Color fundus image: 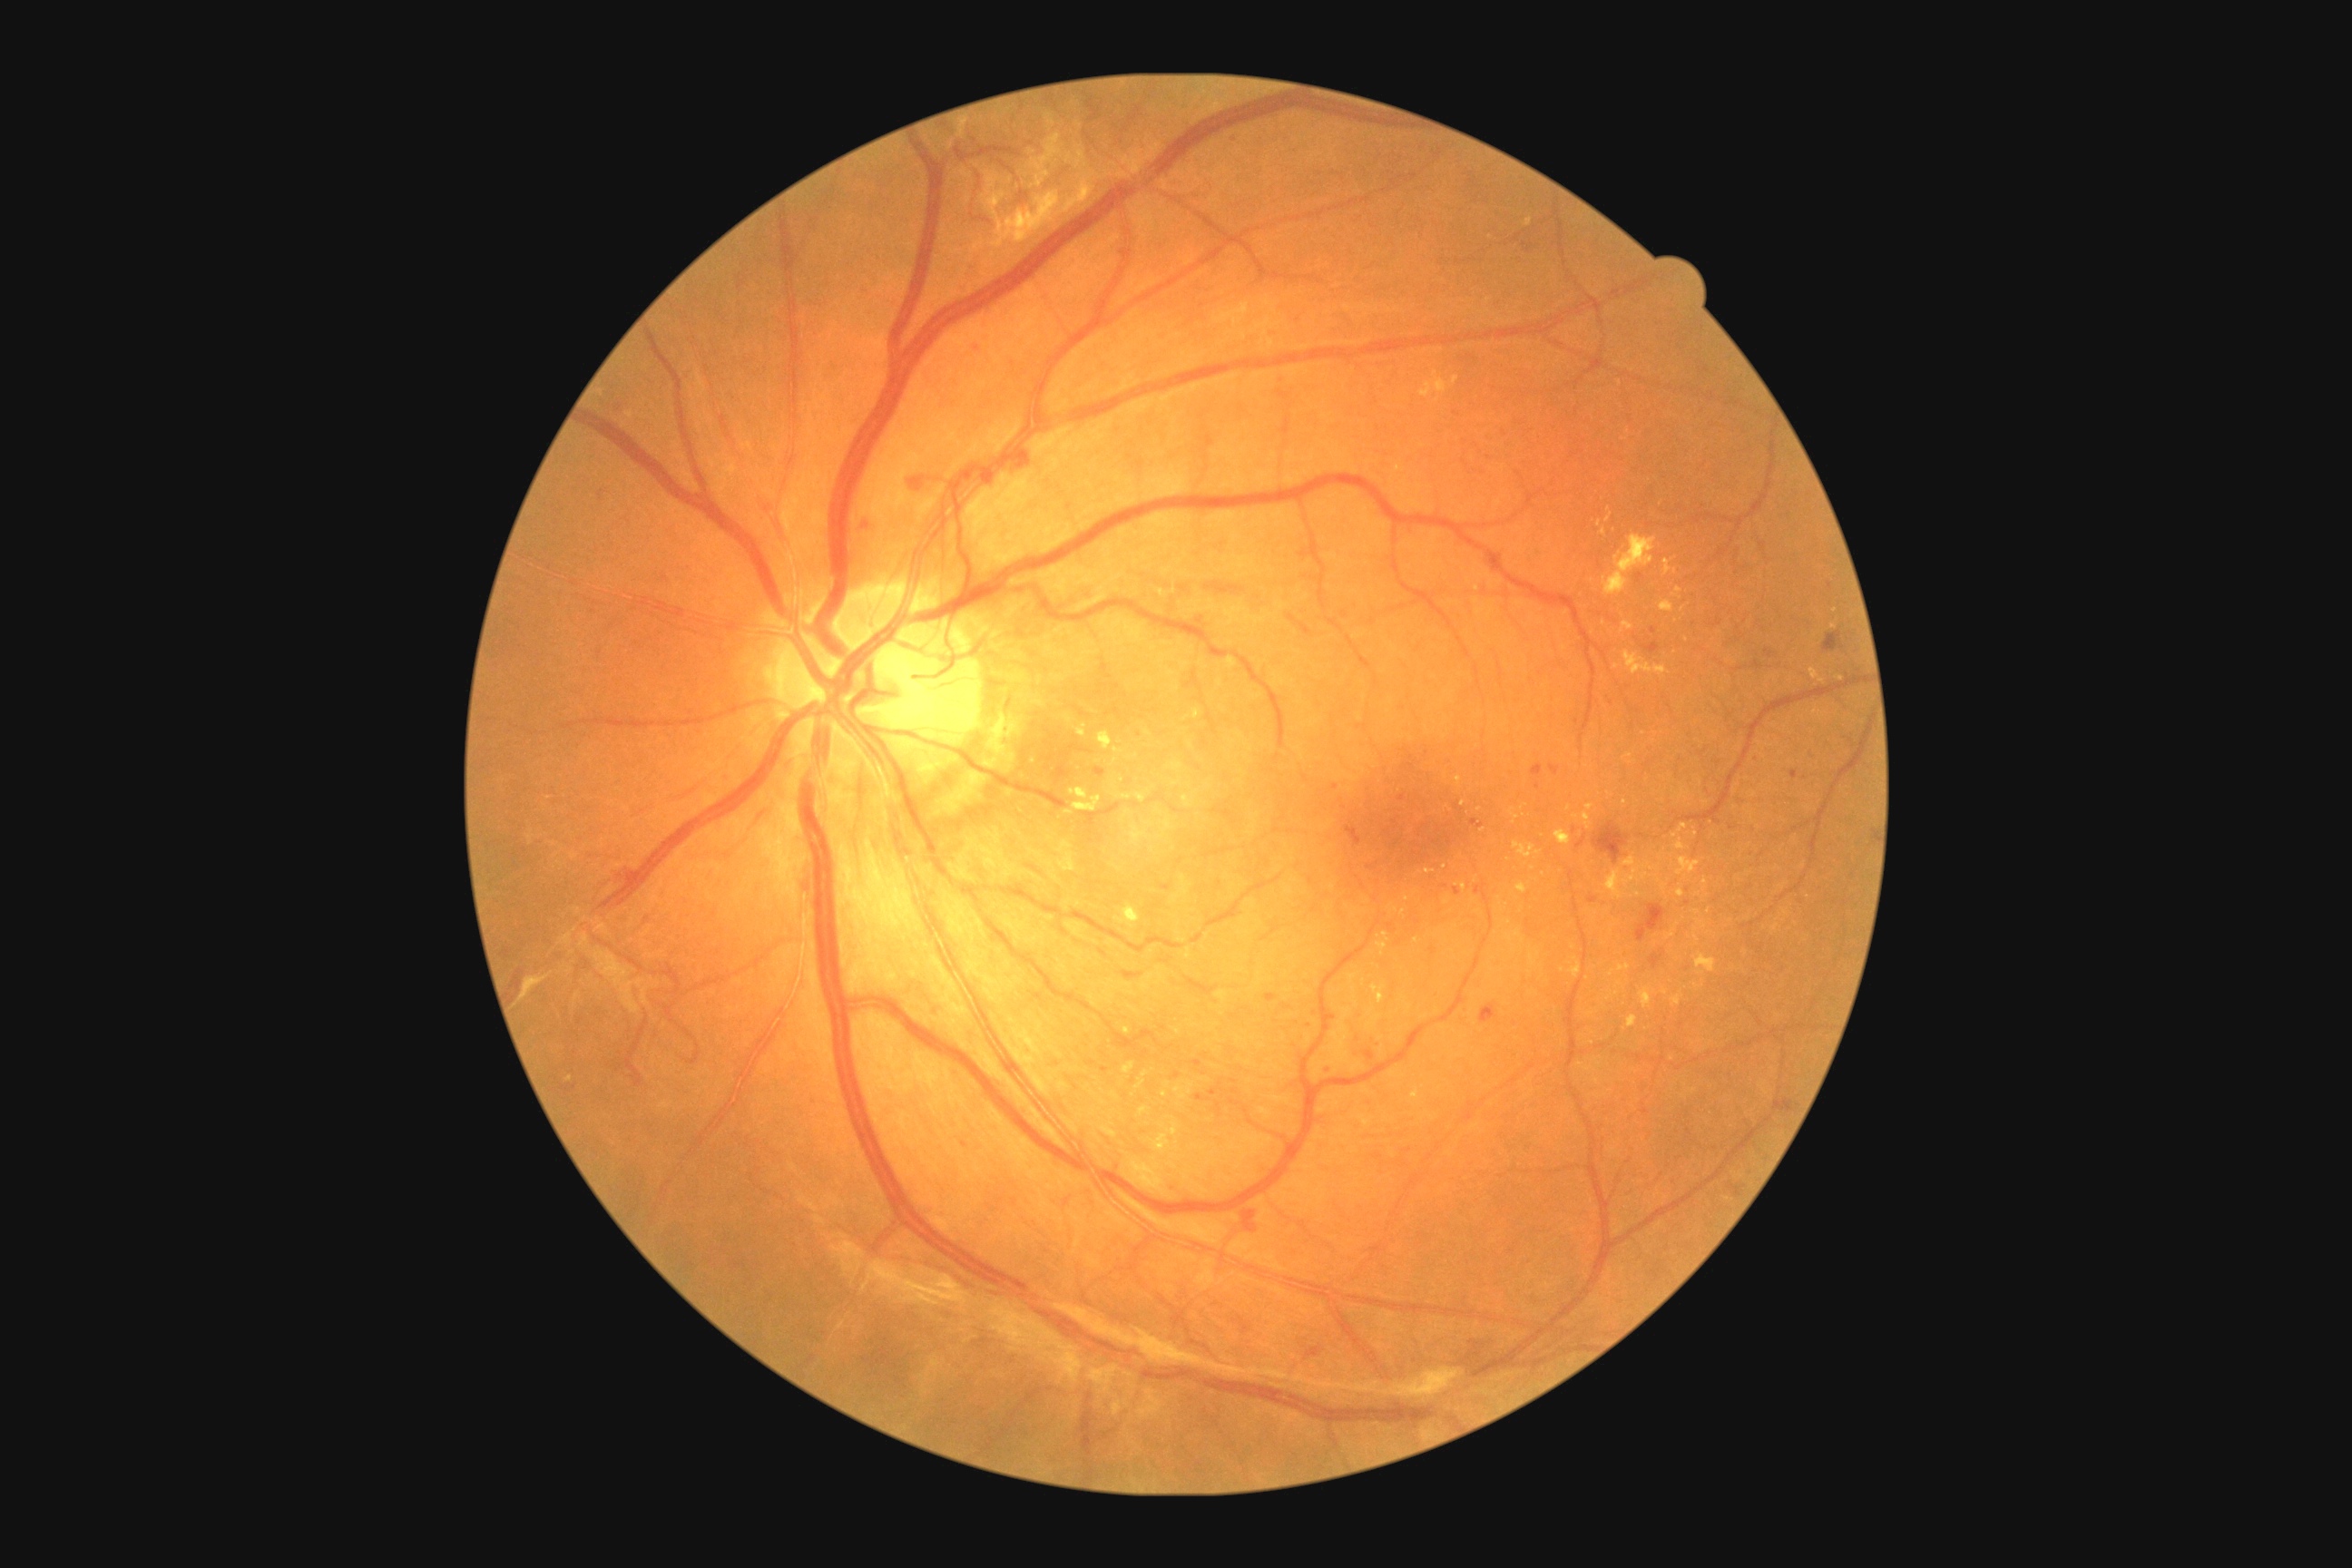
Retinopathy: proliferative diabetic retinopathy (grade 4).